FOV: 45 degrees:
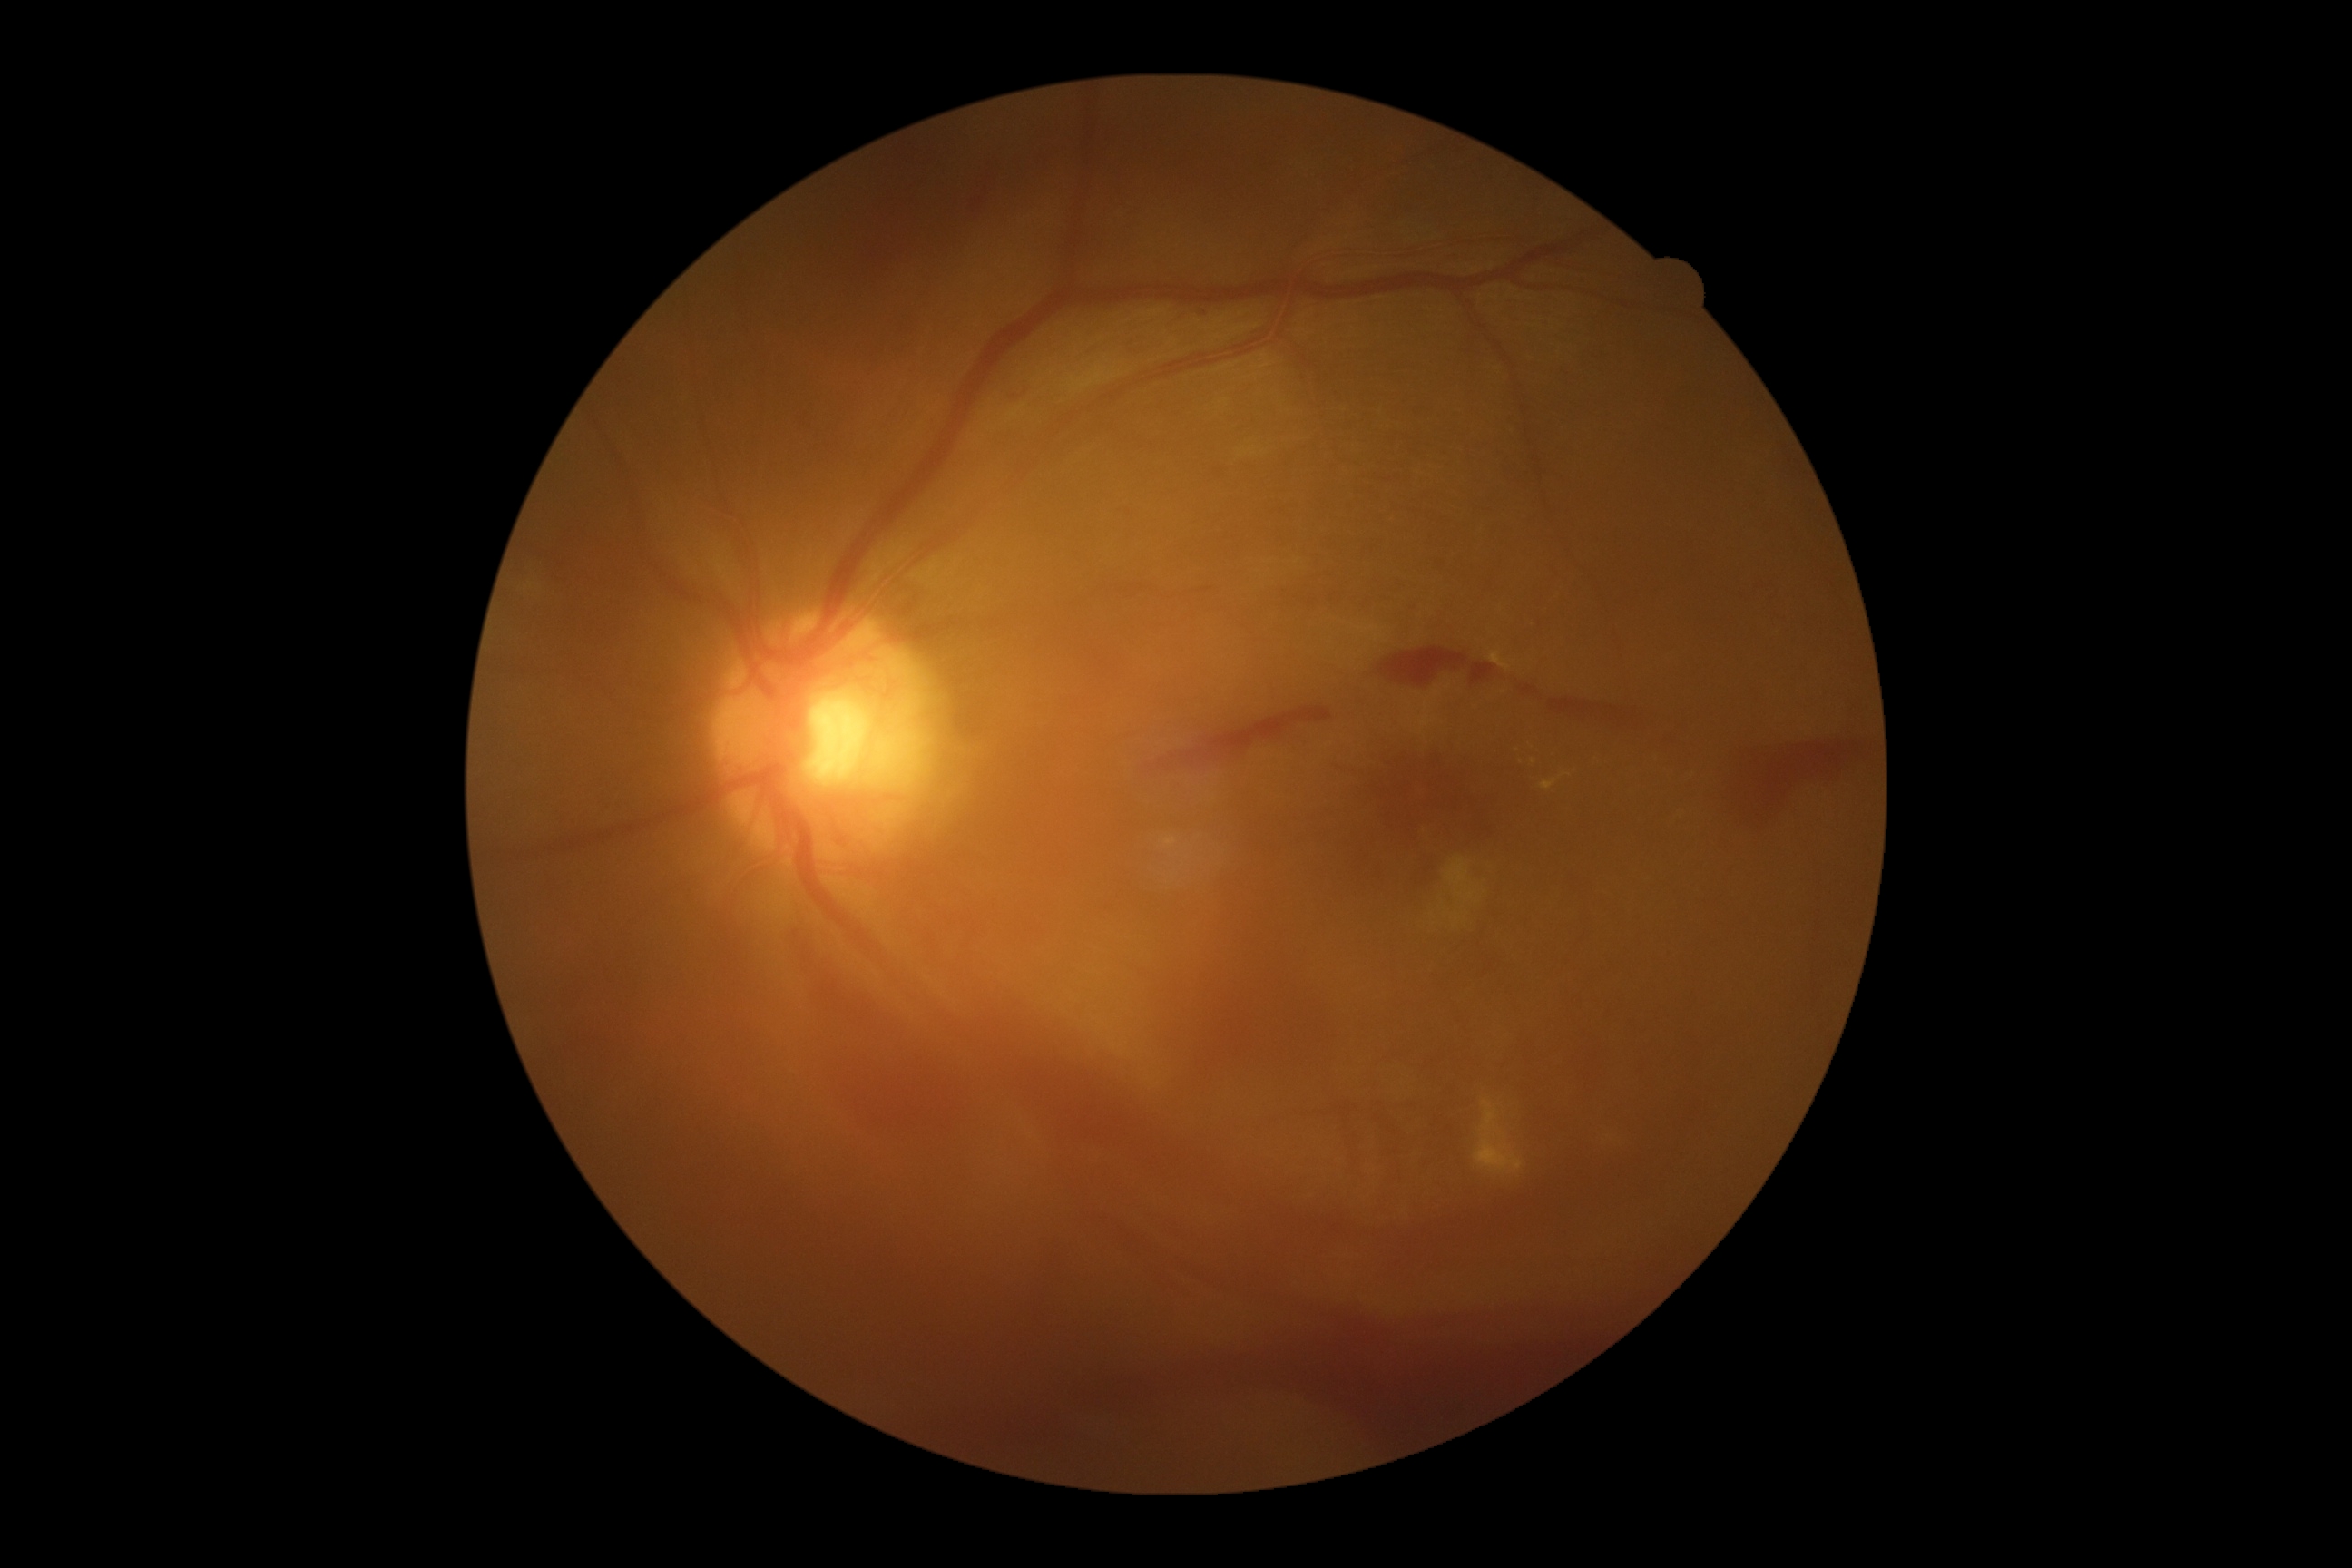

{"dr_grade": "4"}